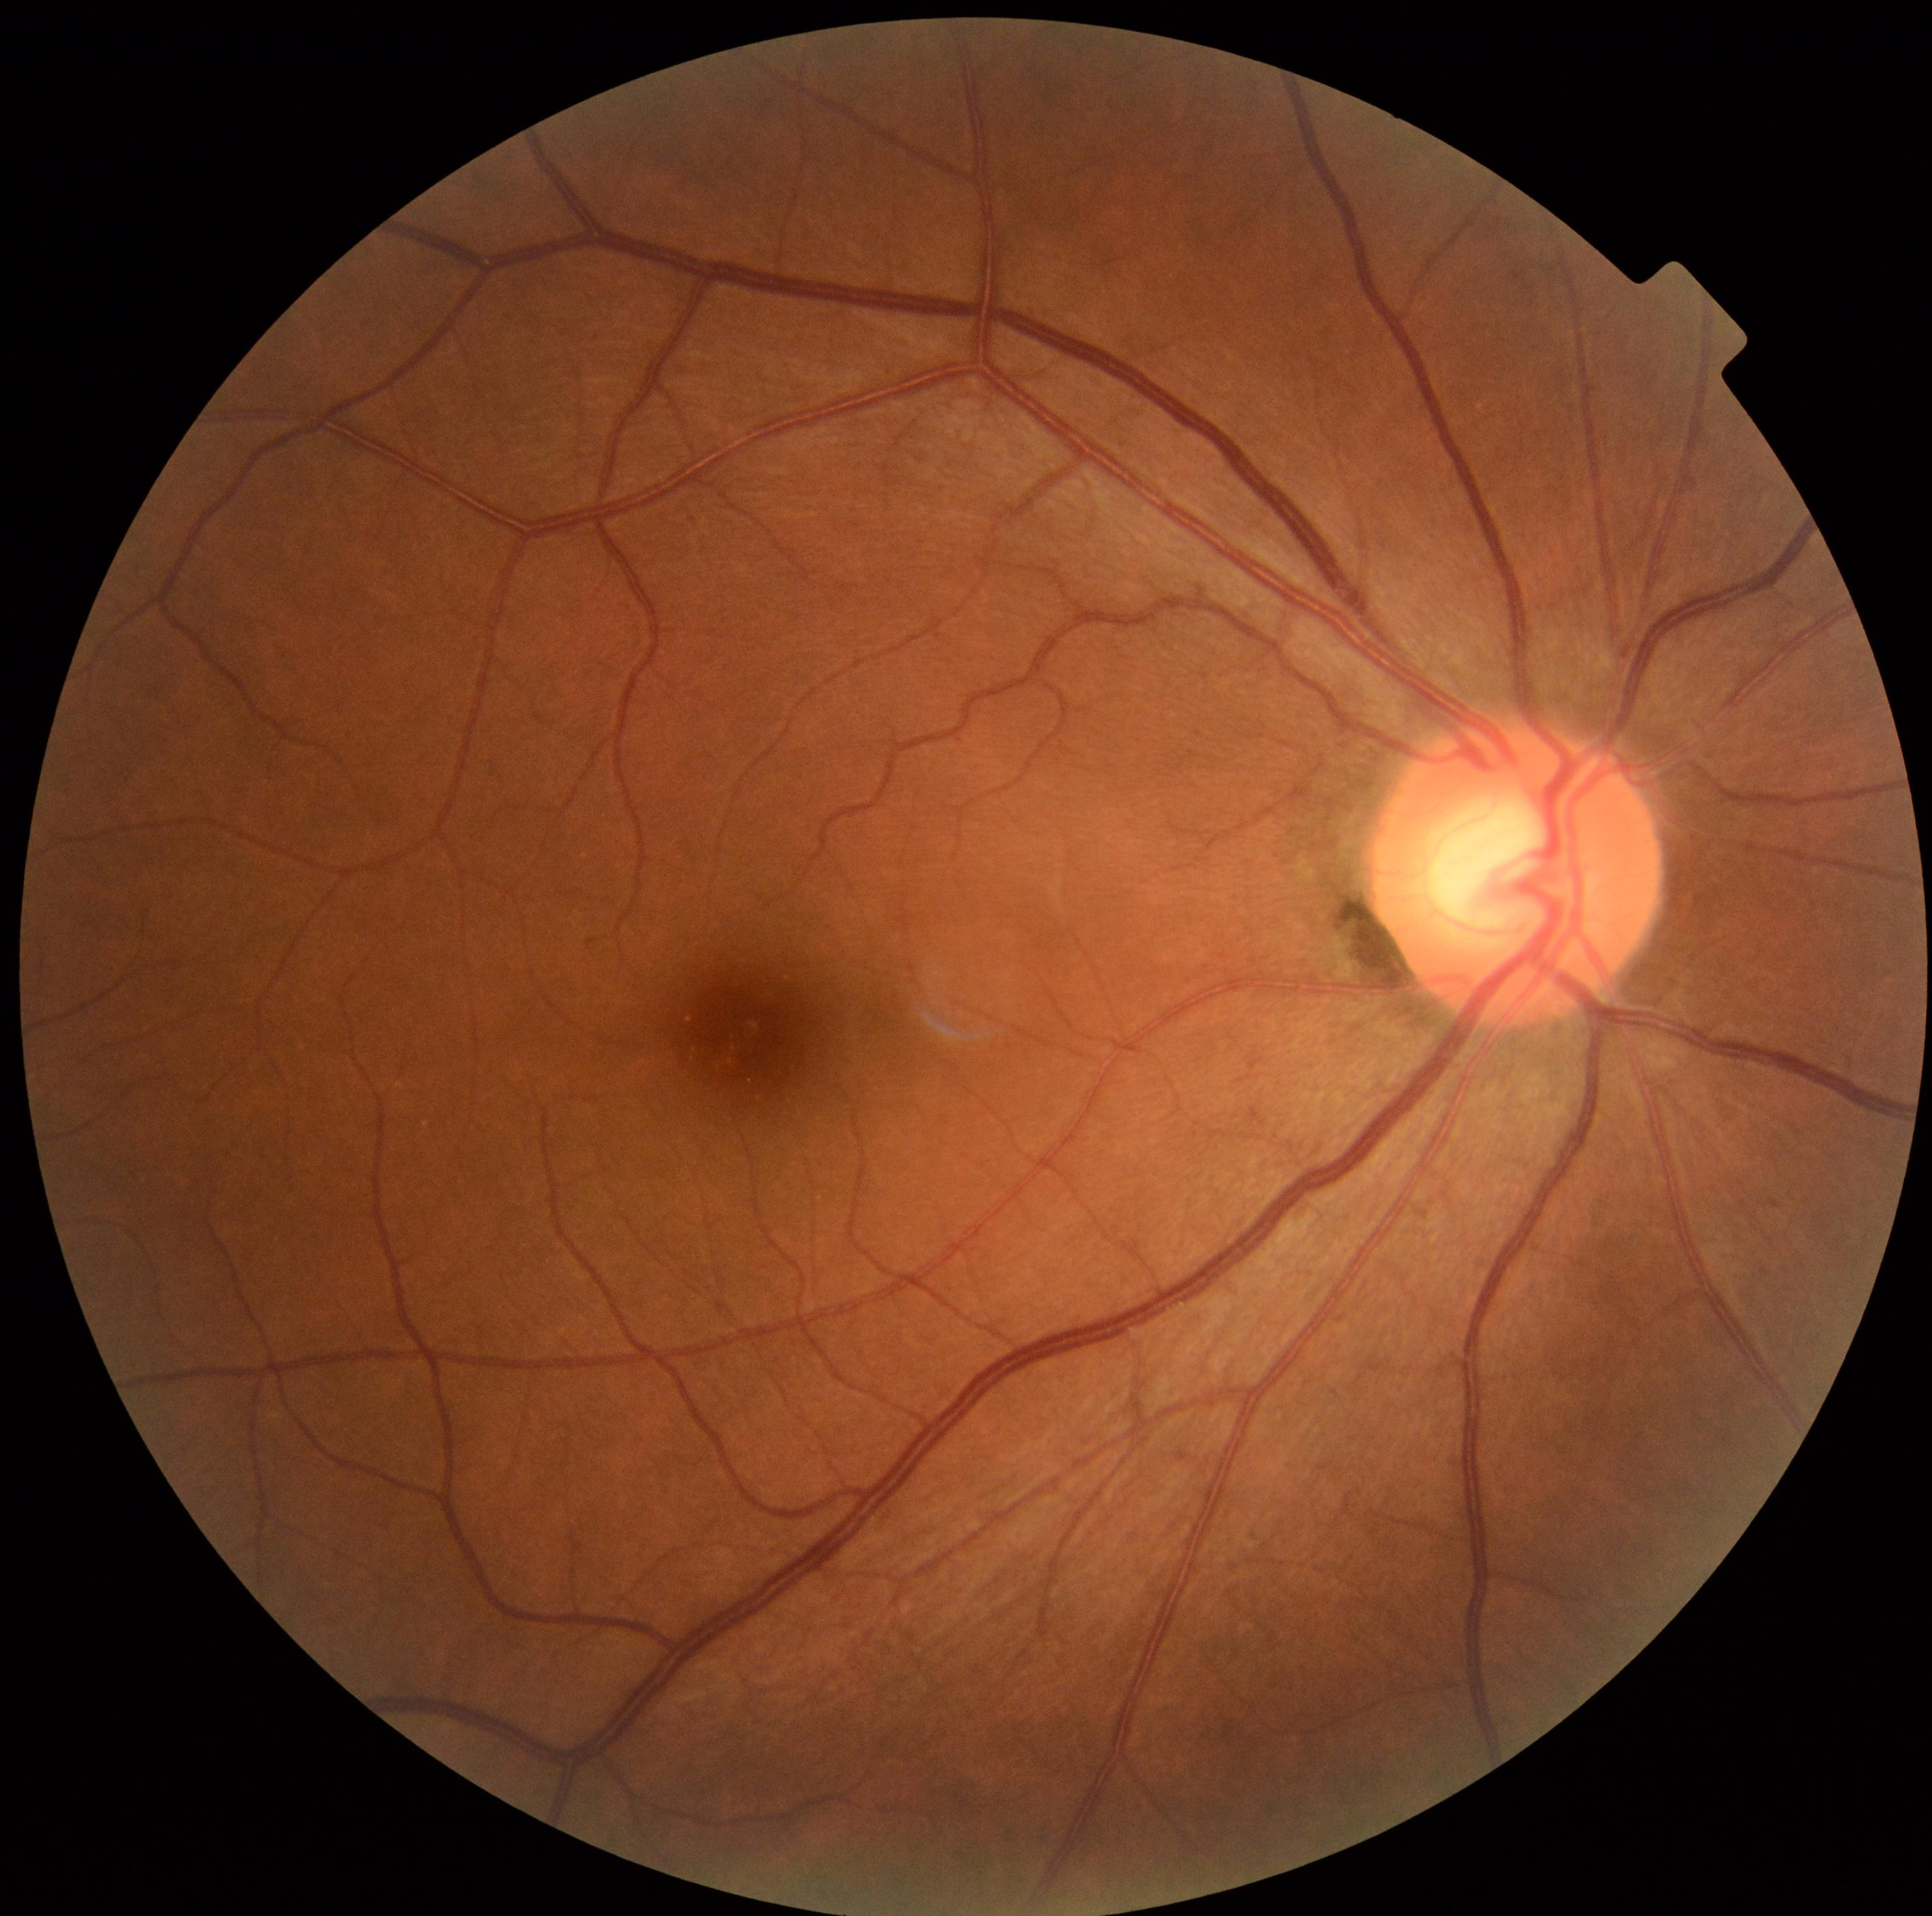

No apparent diabetic retinopathy. Retinopathy is 0.